Wide-field fundus image from infant ROP screening:
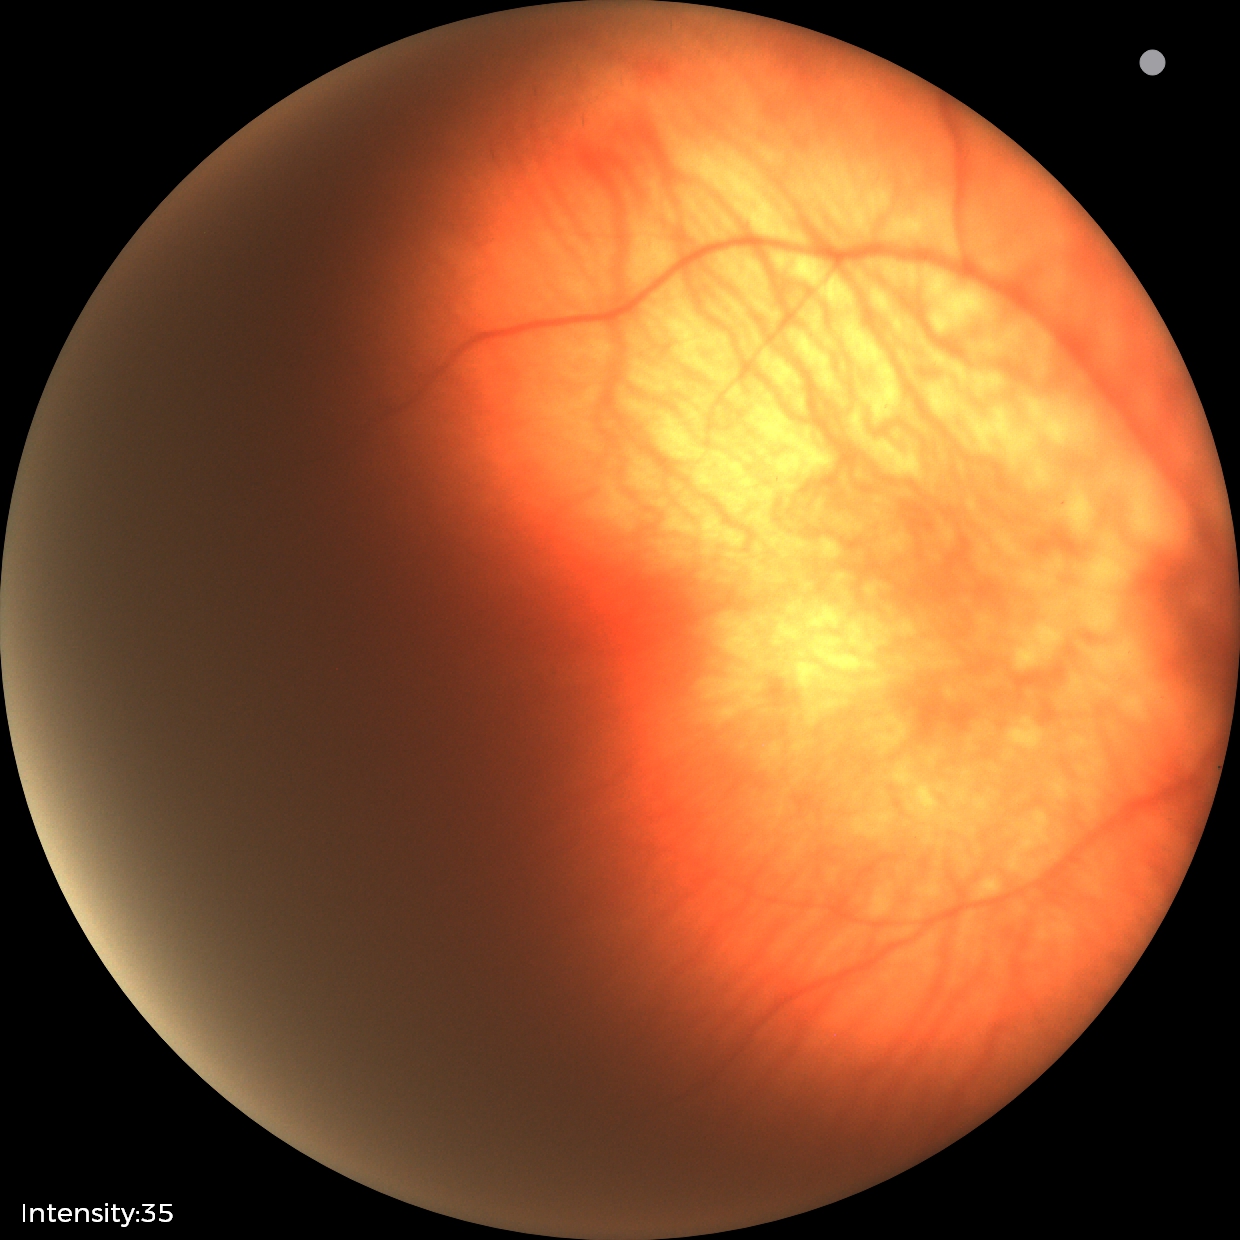
Normal screening examination.